Modified Davis grading:
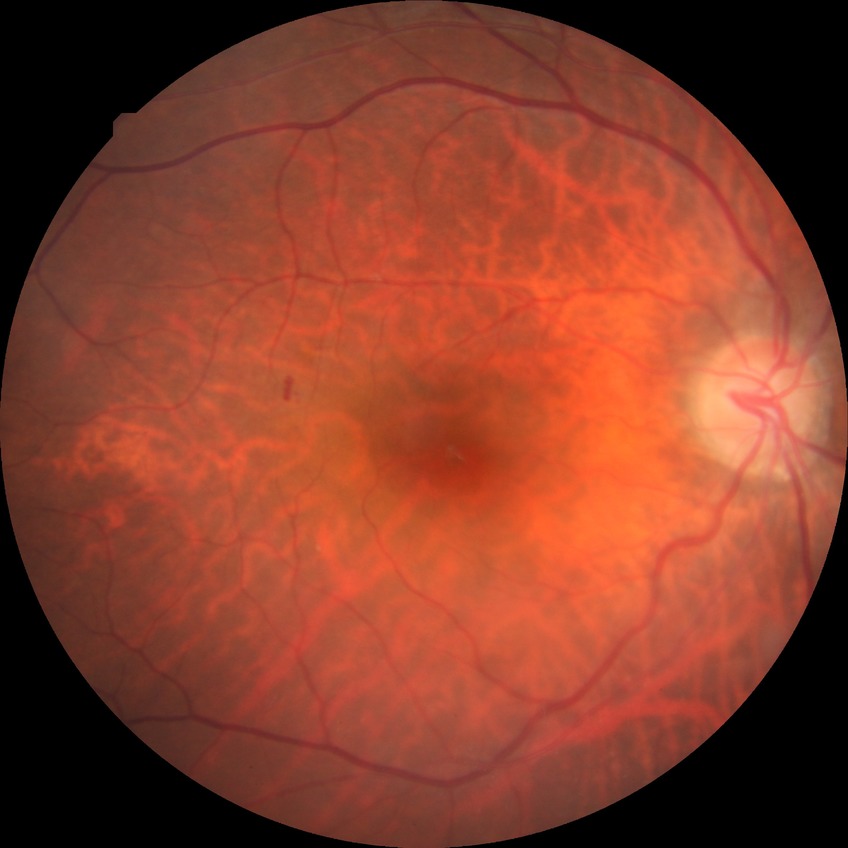 DR class: non-proliferative diabetic retinopathy. Diabetic retinopathy (DR): SDR (simple diabetic retinopathy).